2184 by 1690 pixels; retinal fundus photograph; FOV: 45 degrees
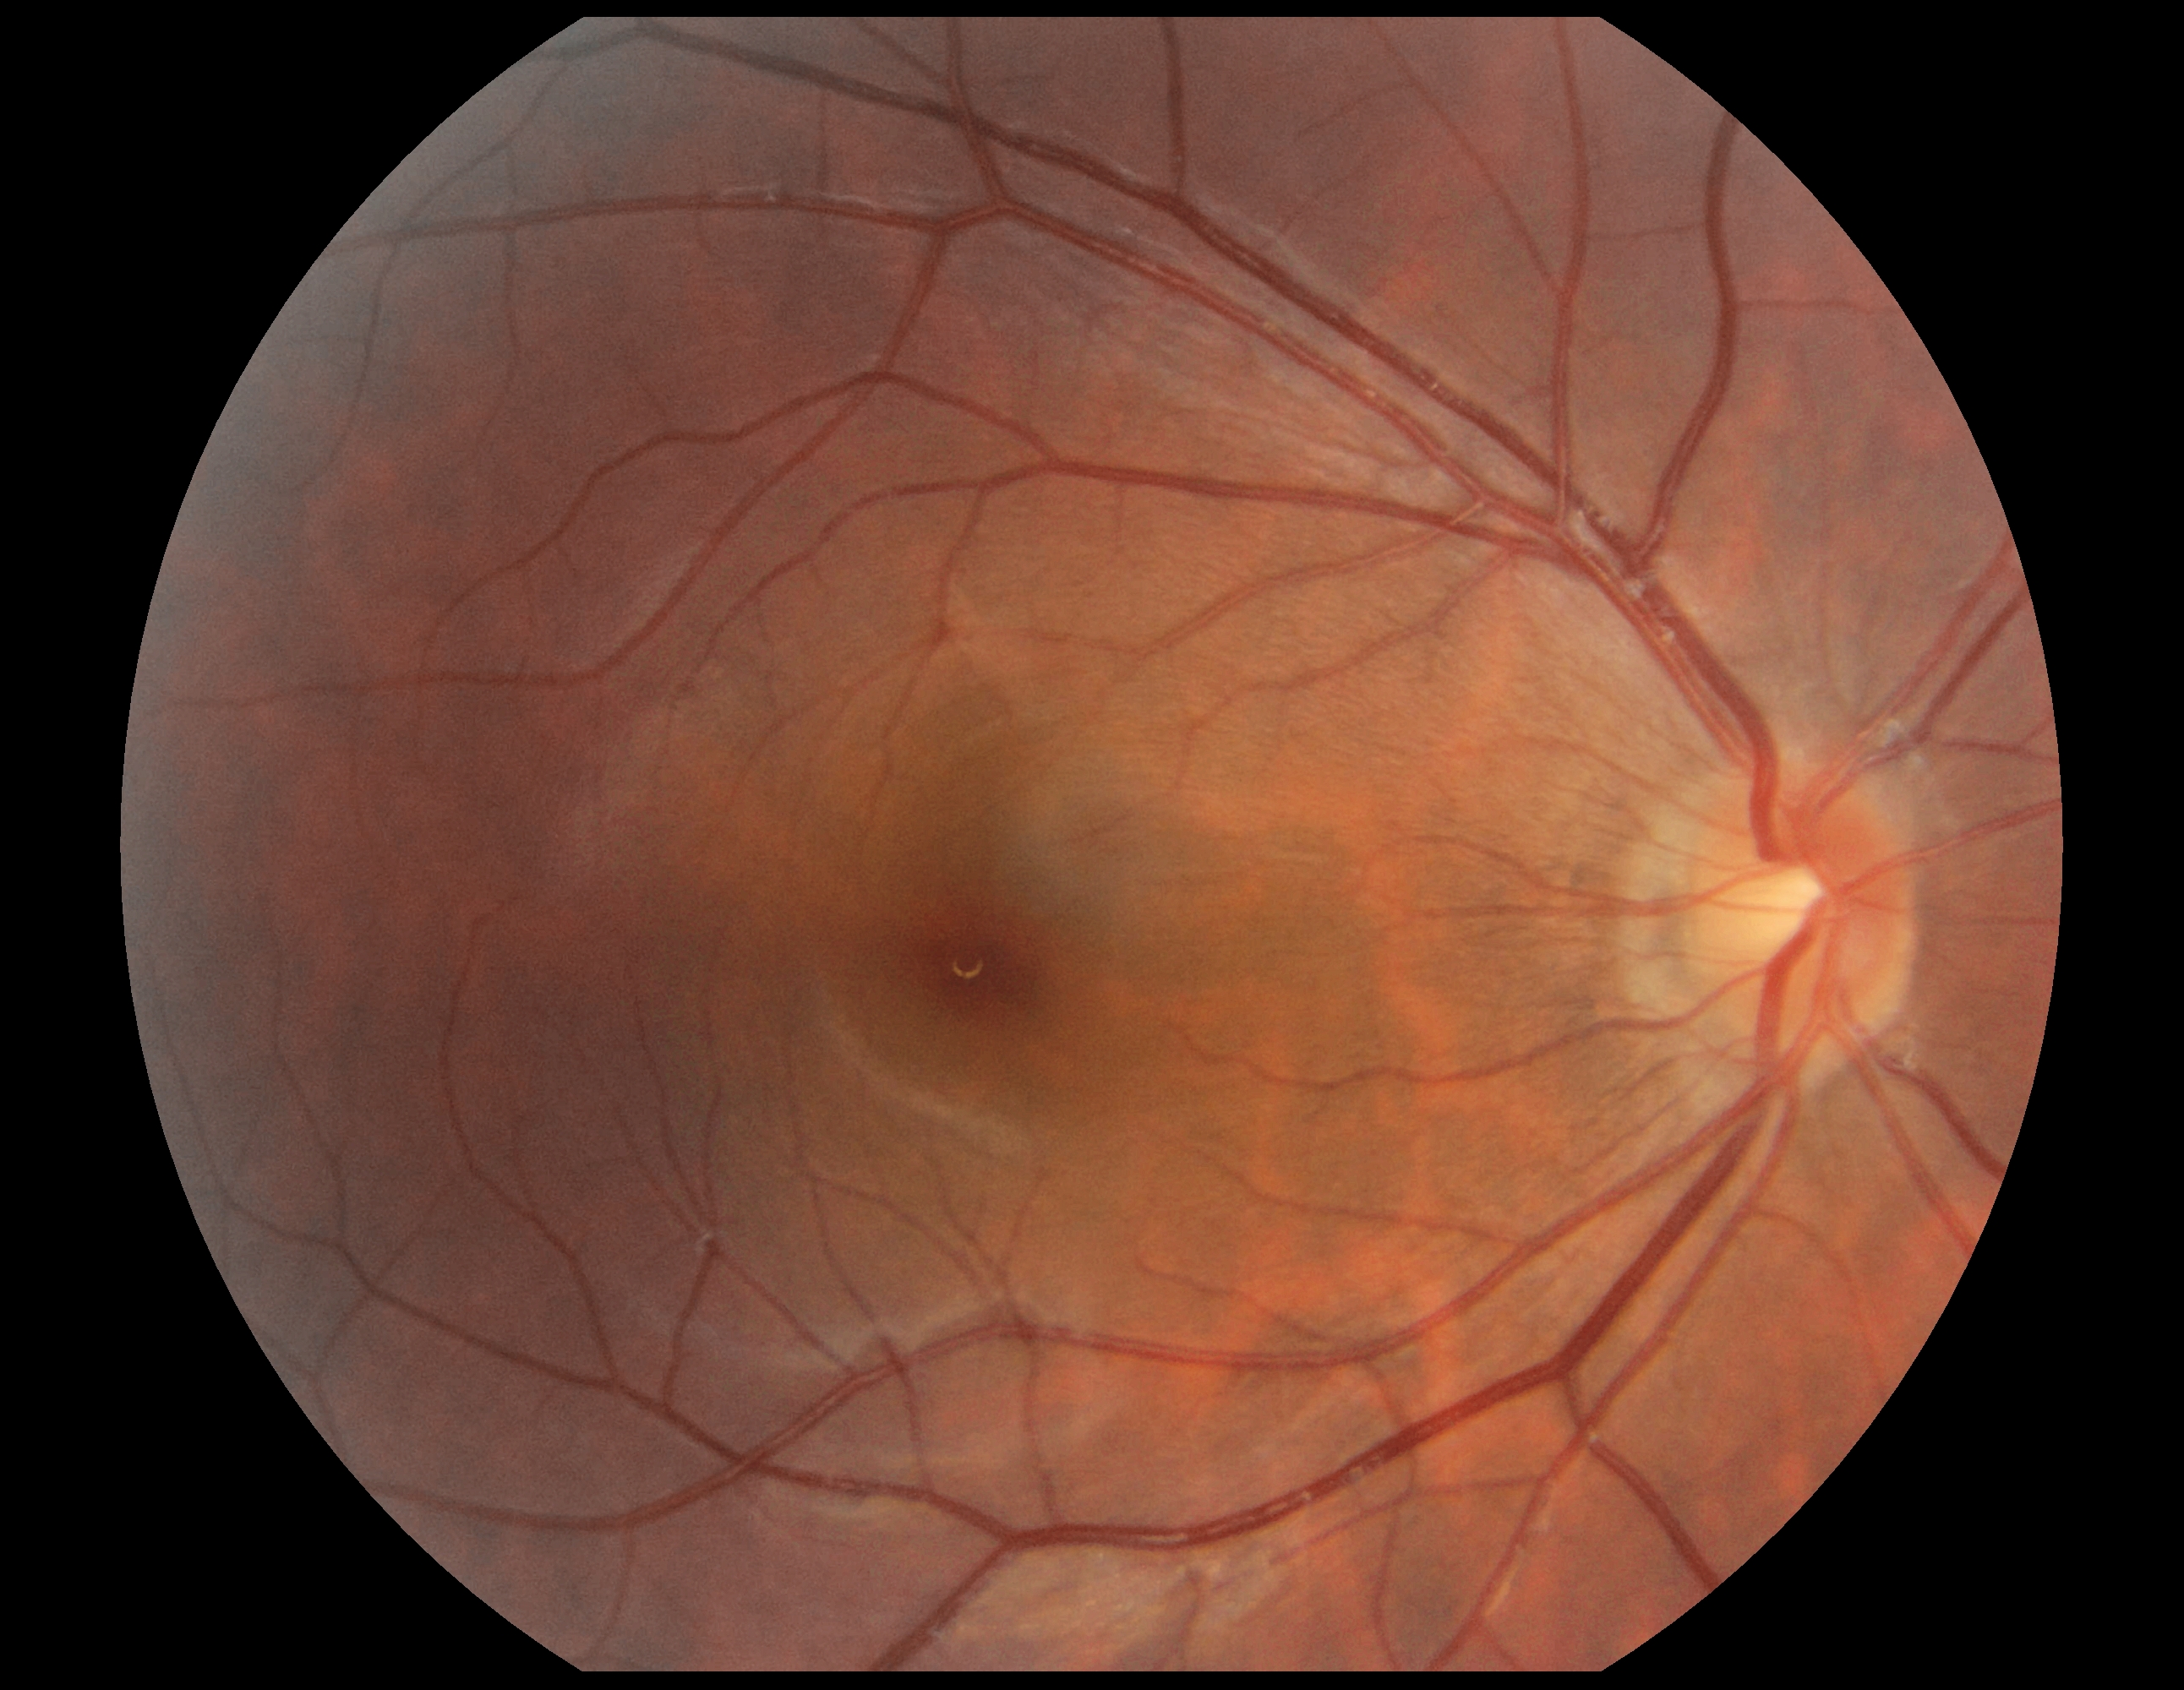 Diabetic retinopathy (DR): grade 0.